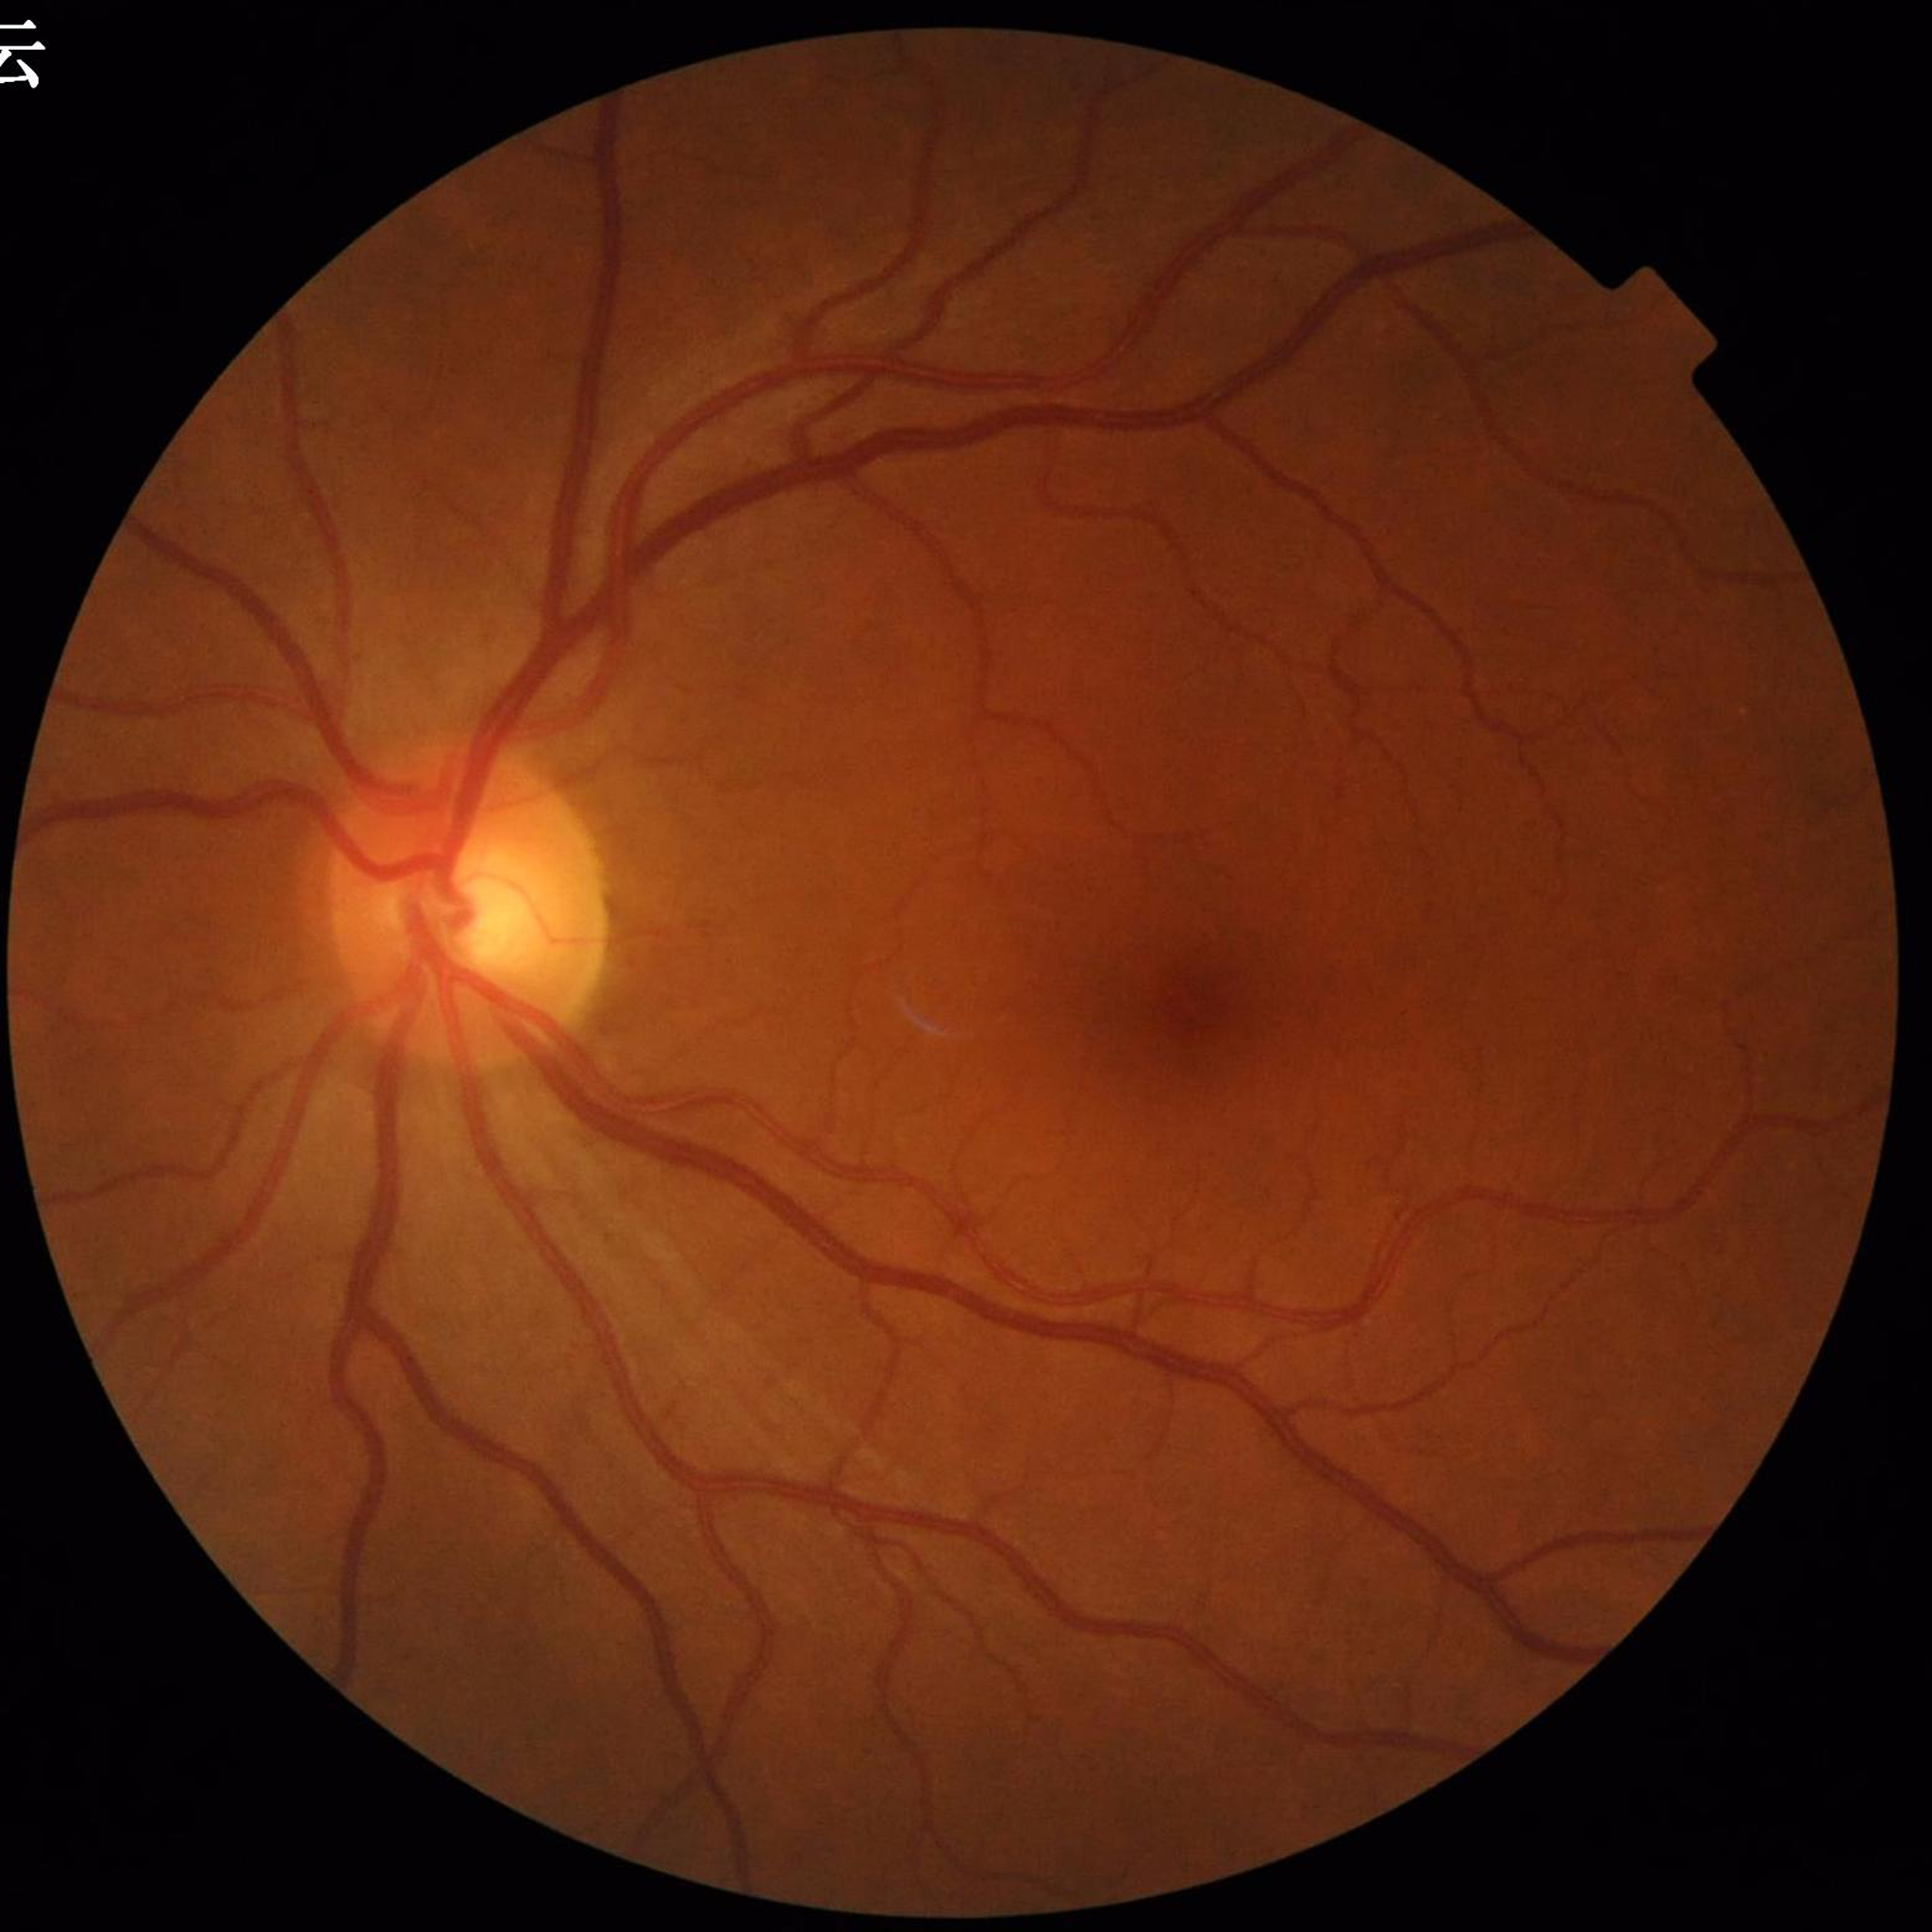
This fundus photograph is from a patient diagnosed with glaucoma. Automated quality assessment: good.